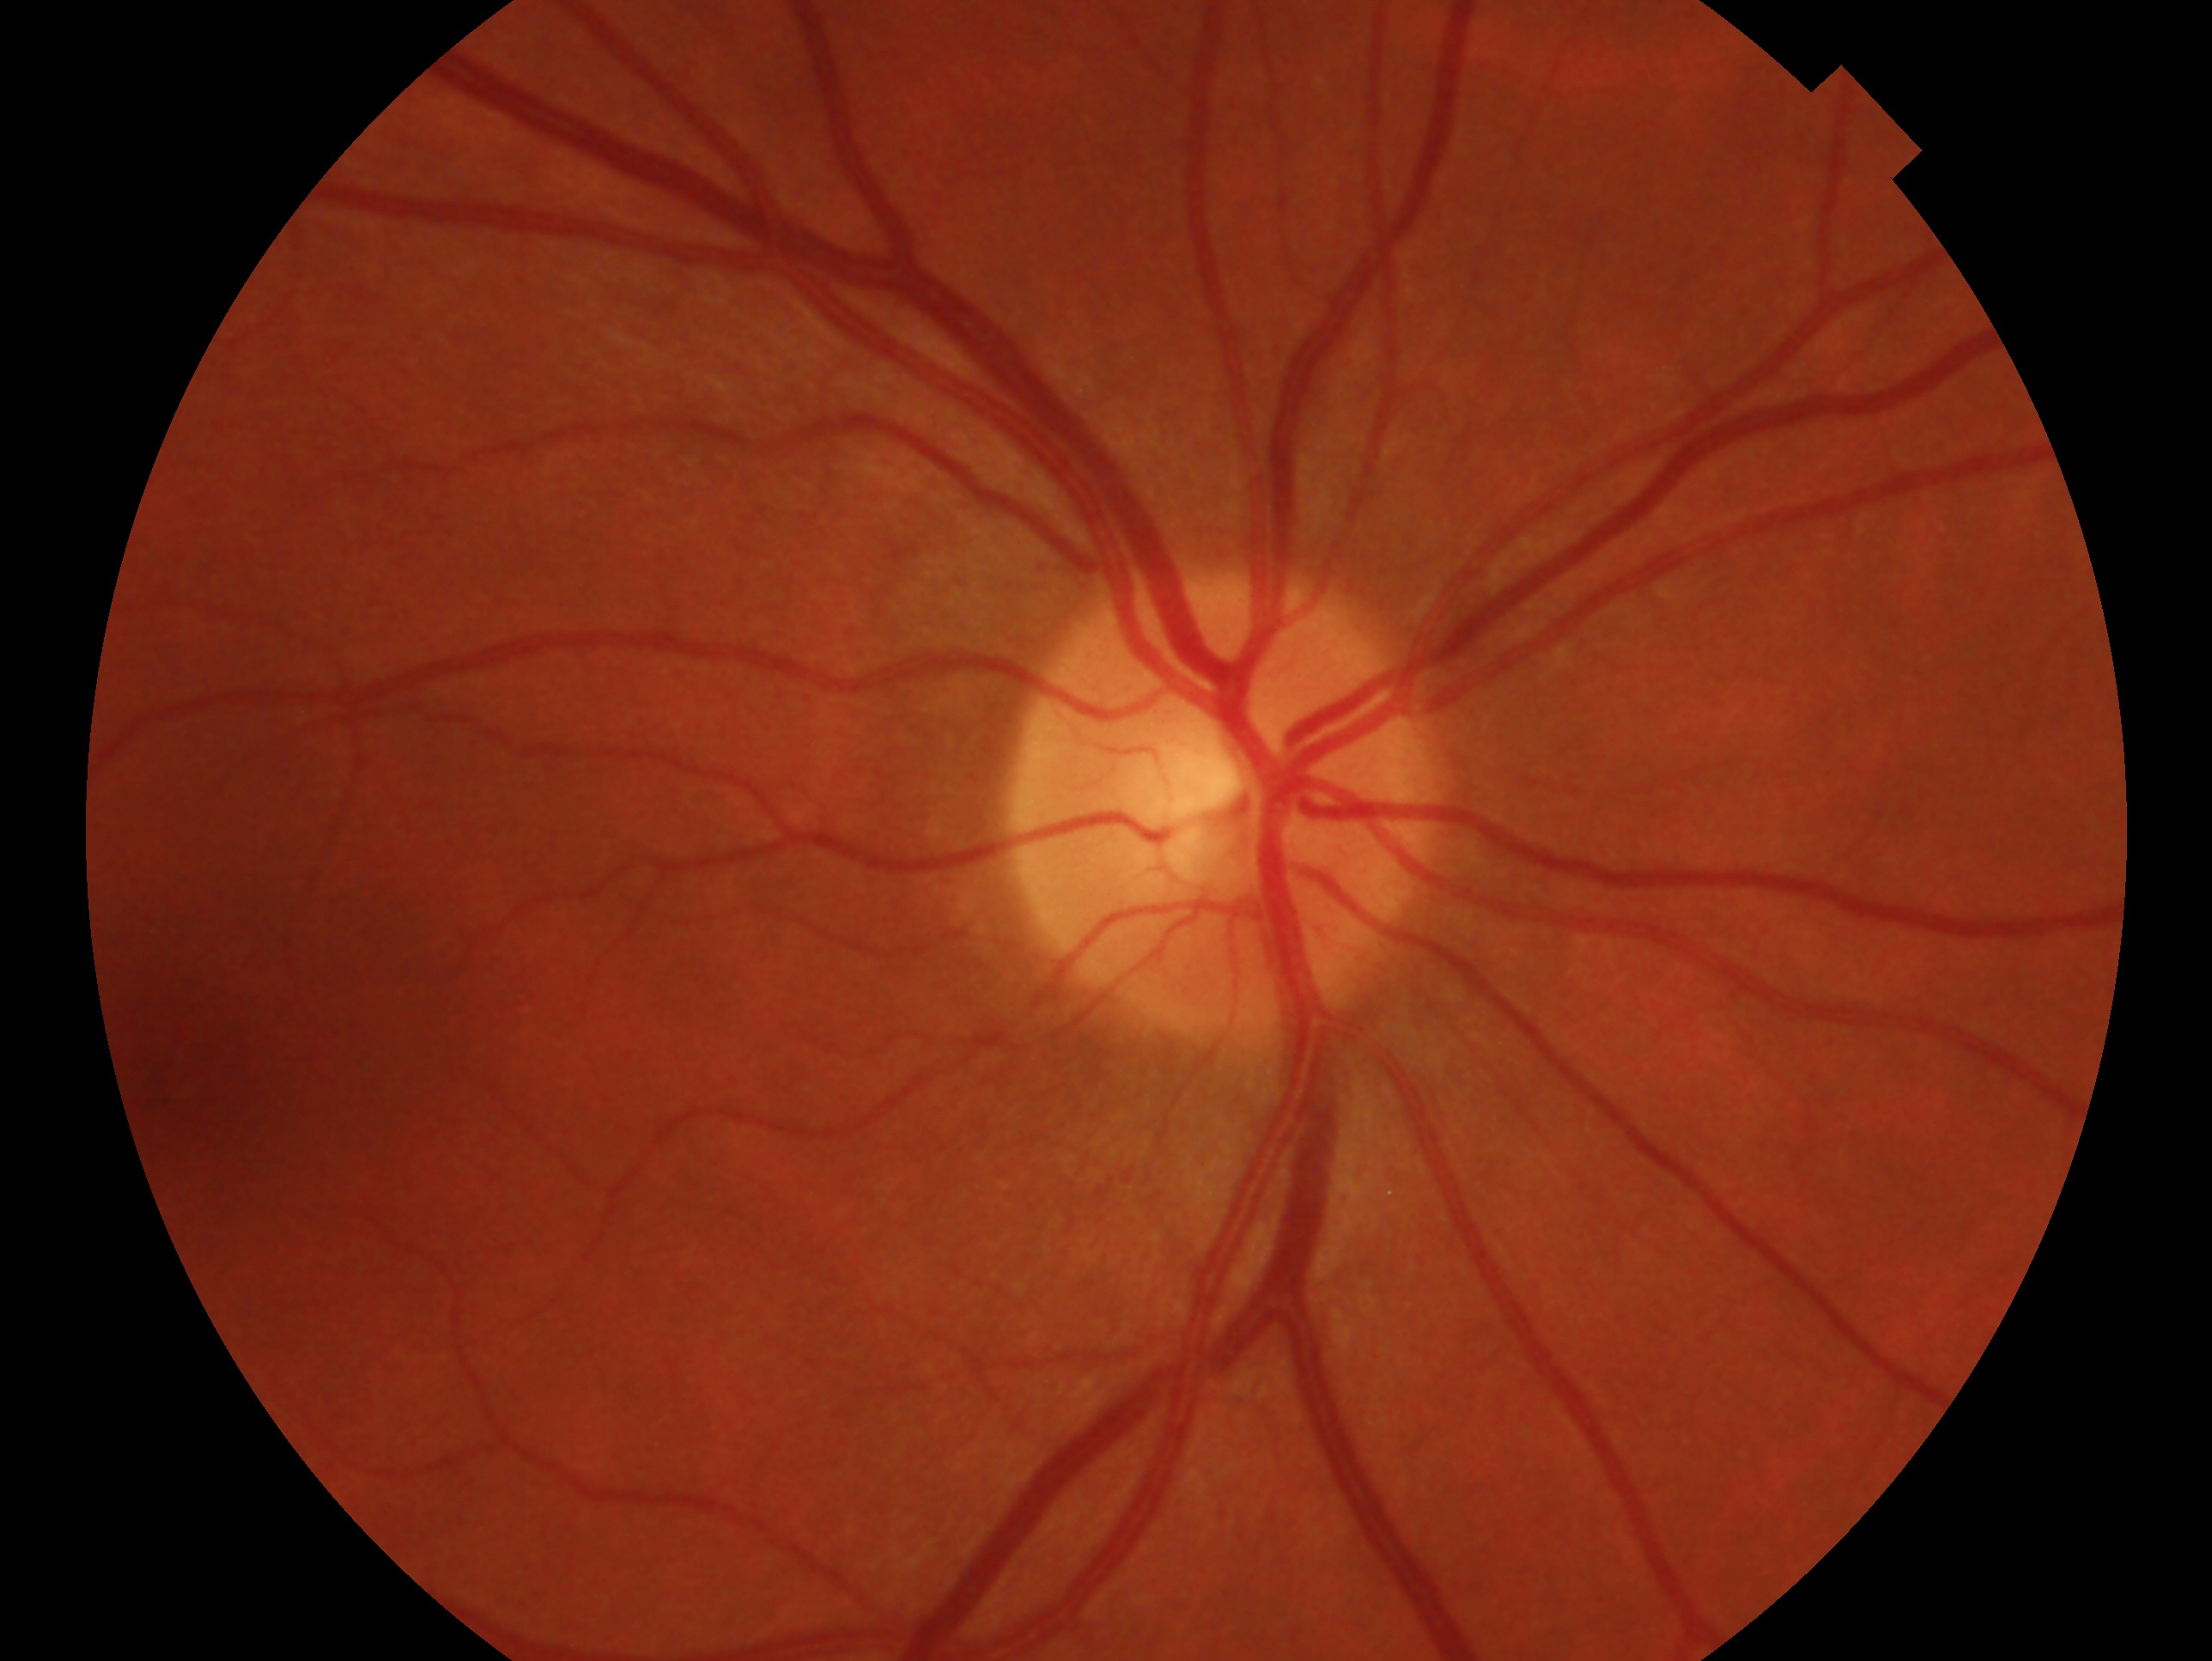 eye: OD; glaucoma status: no signs of glaucoma.